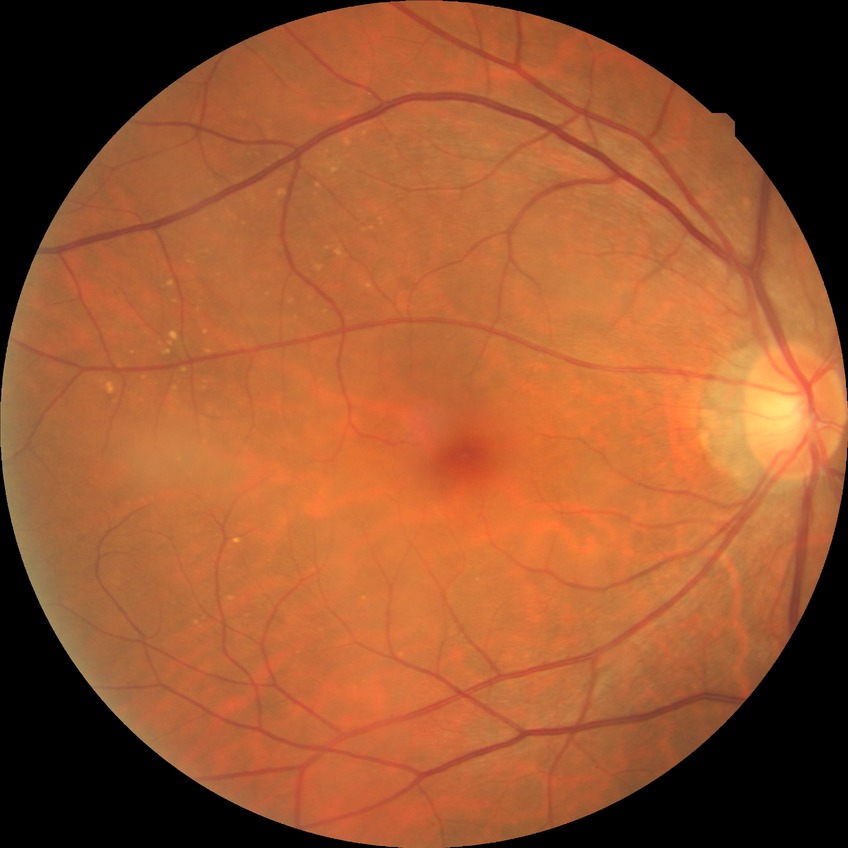 No signs of diabetic retinopathy. DR: NDR.